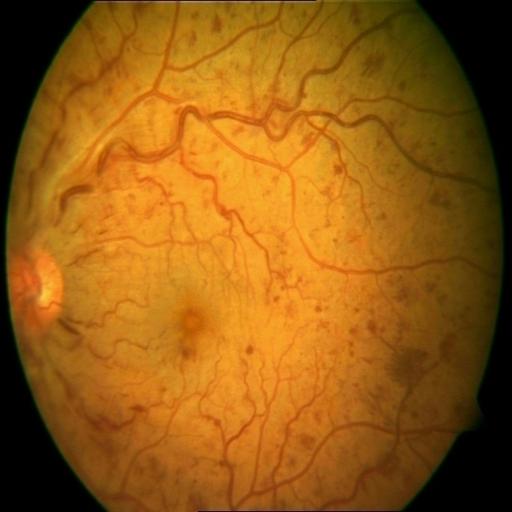

Impression: central retinal vein occlusion.